Image size 2228x1652; color fundus photograph; mydriatic (tropicamide and phenylephrine); FOV: 50 degrees; posterior pole view: 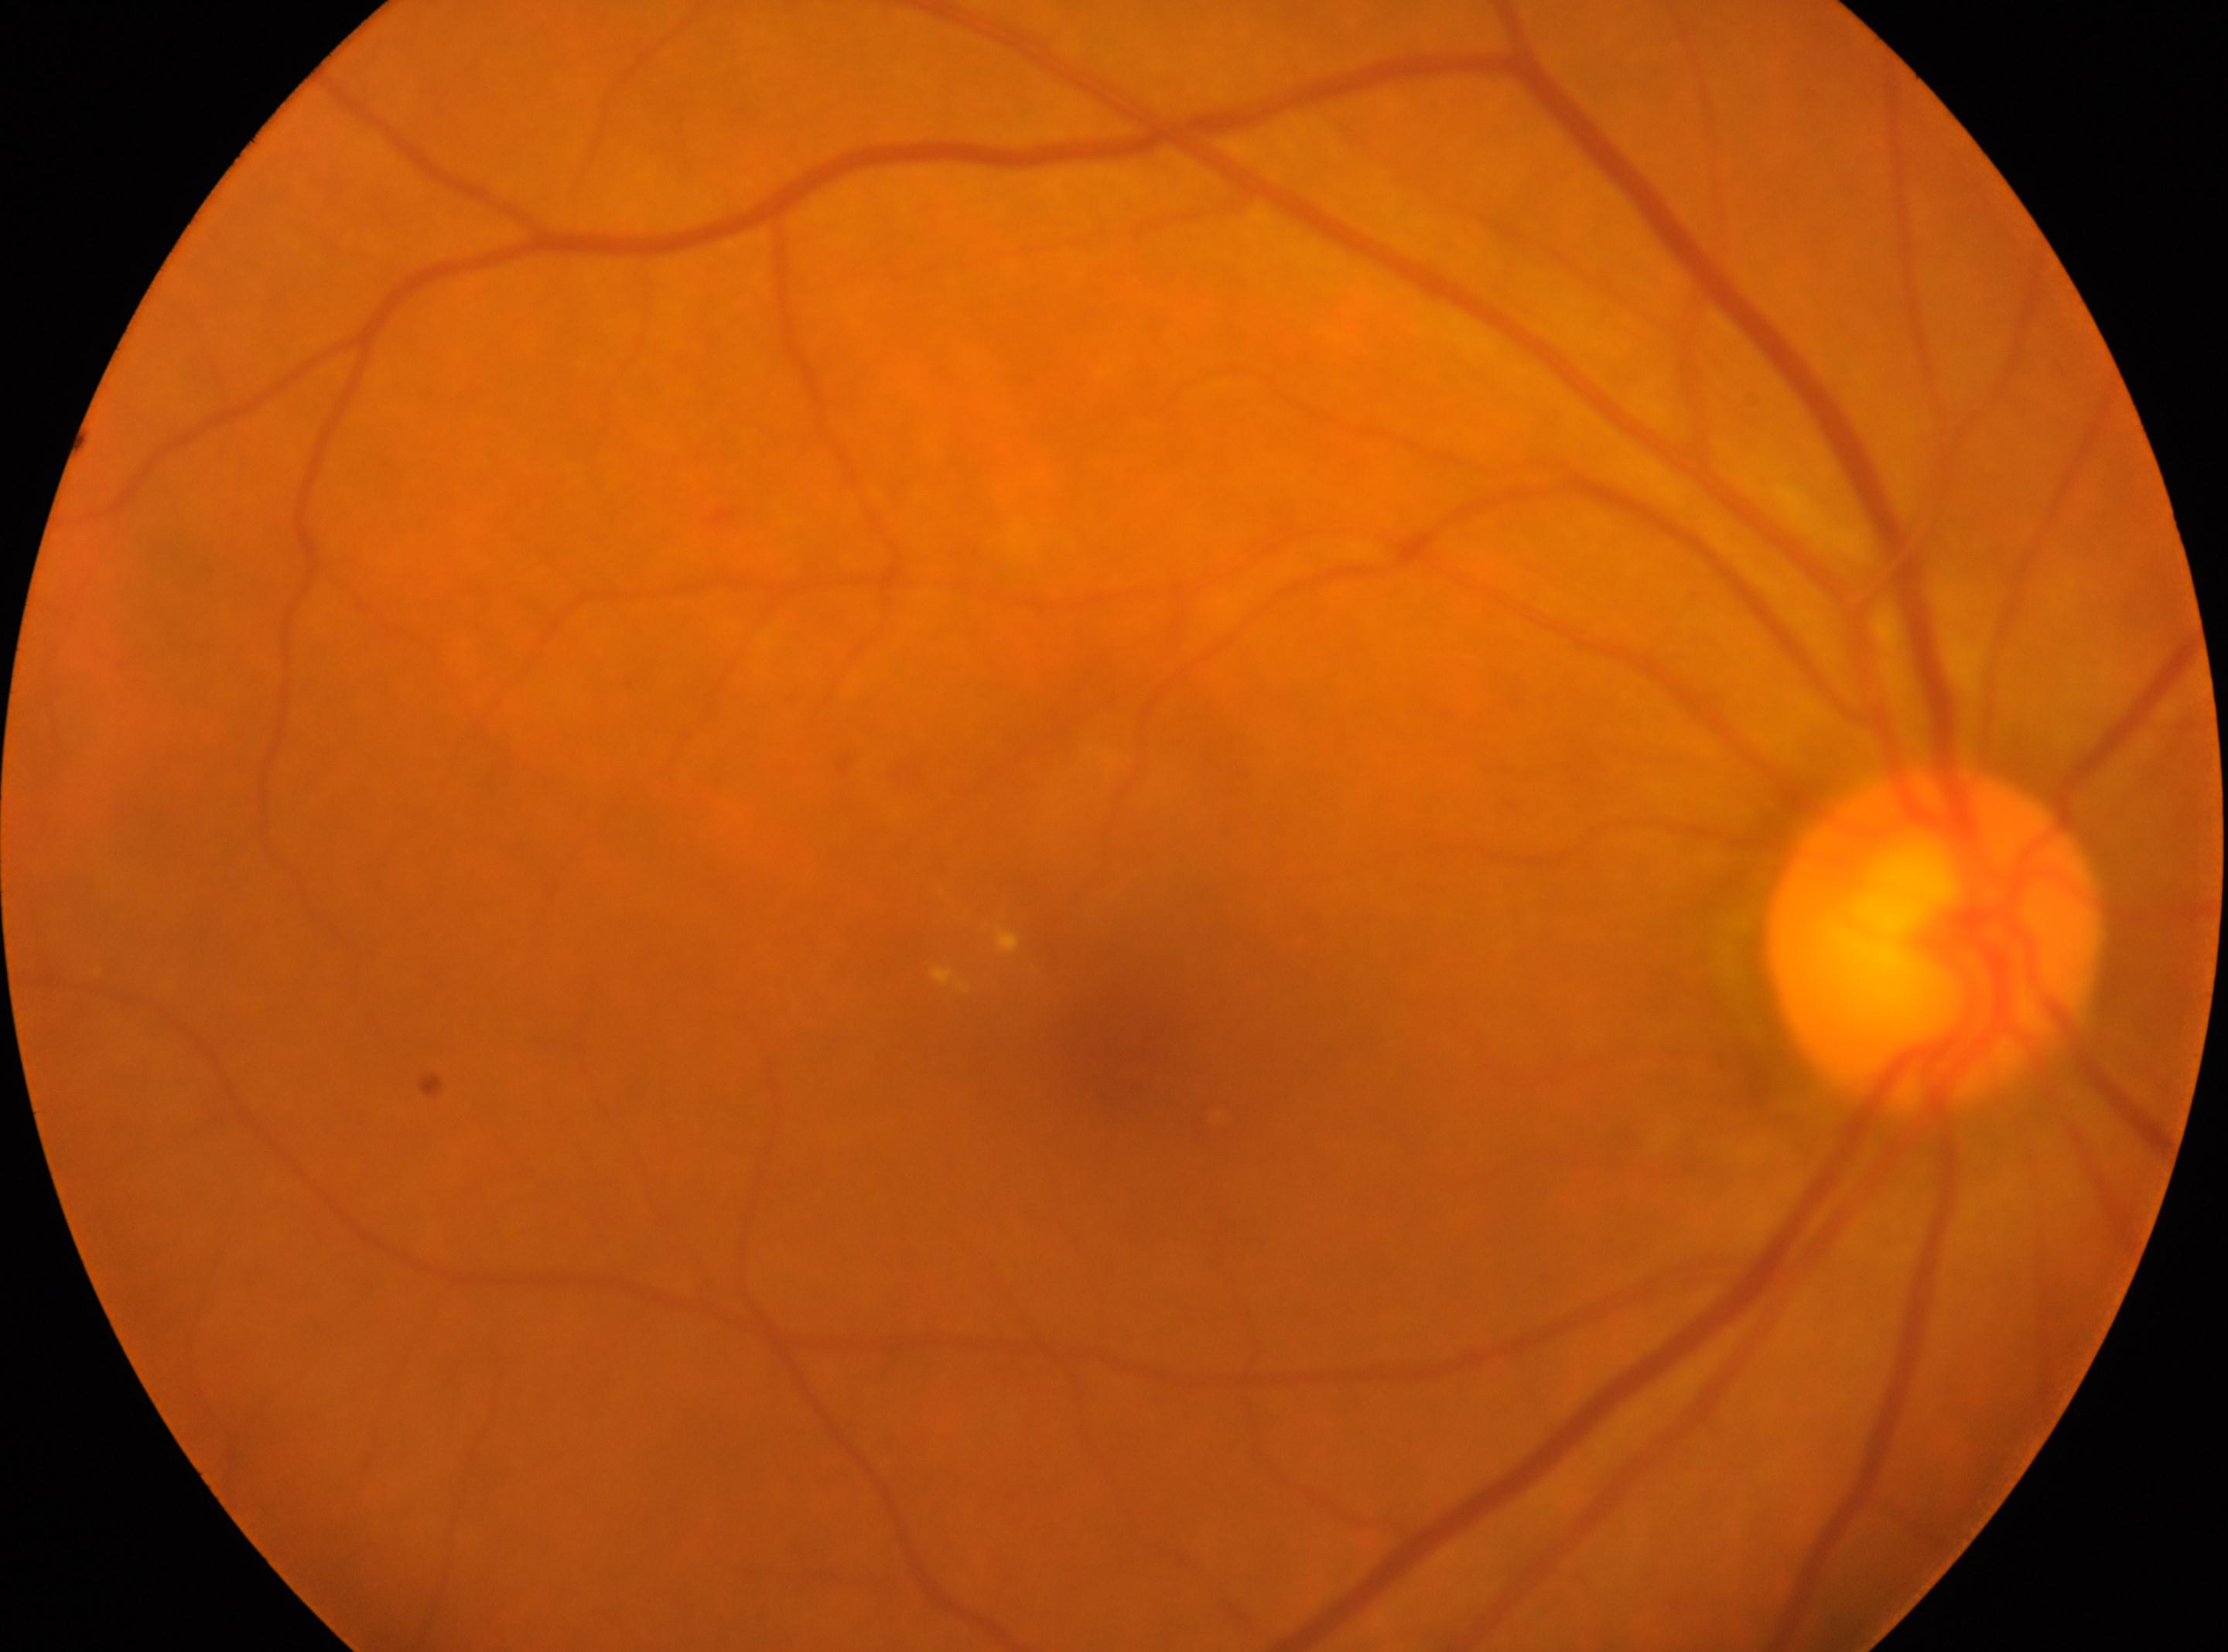

Optic nerve head: (x: 1932, y: 937). Imaged eye: right. Diabetic retinopathy (DR) is grade 2 (moderate NPDR). Fovea: (x: 1123, y: 1047).